45-degree field of view
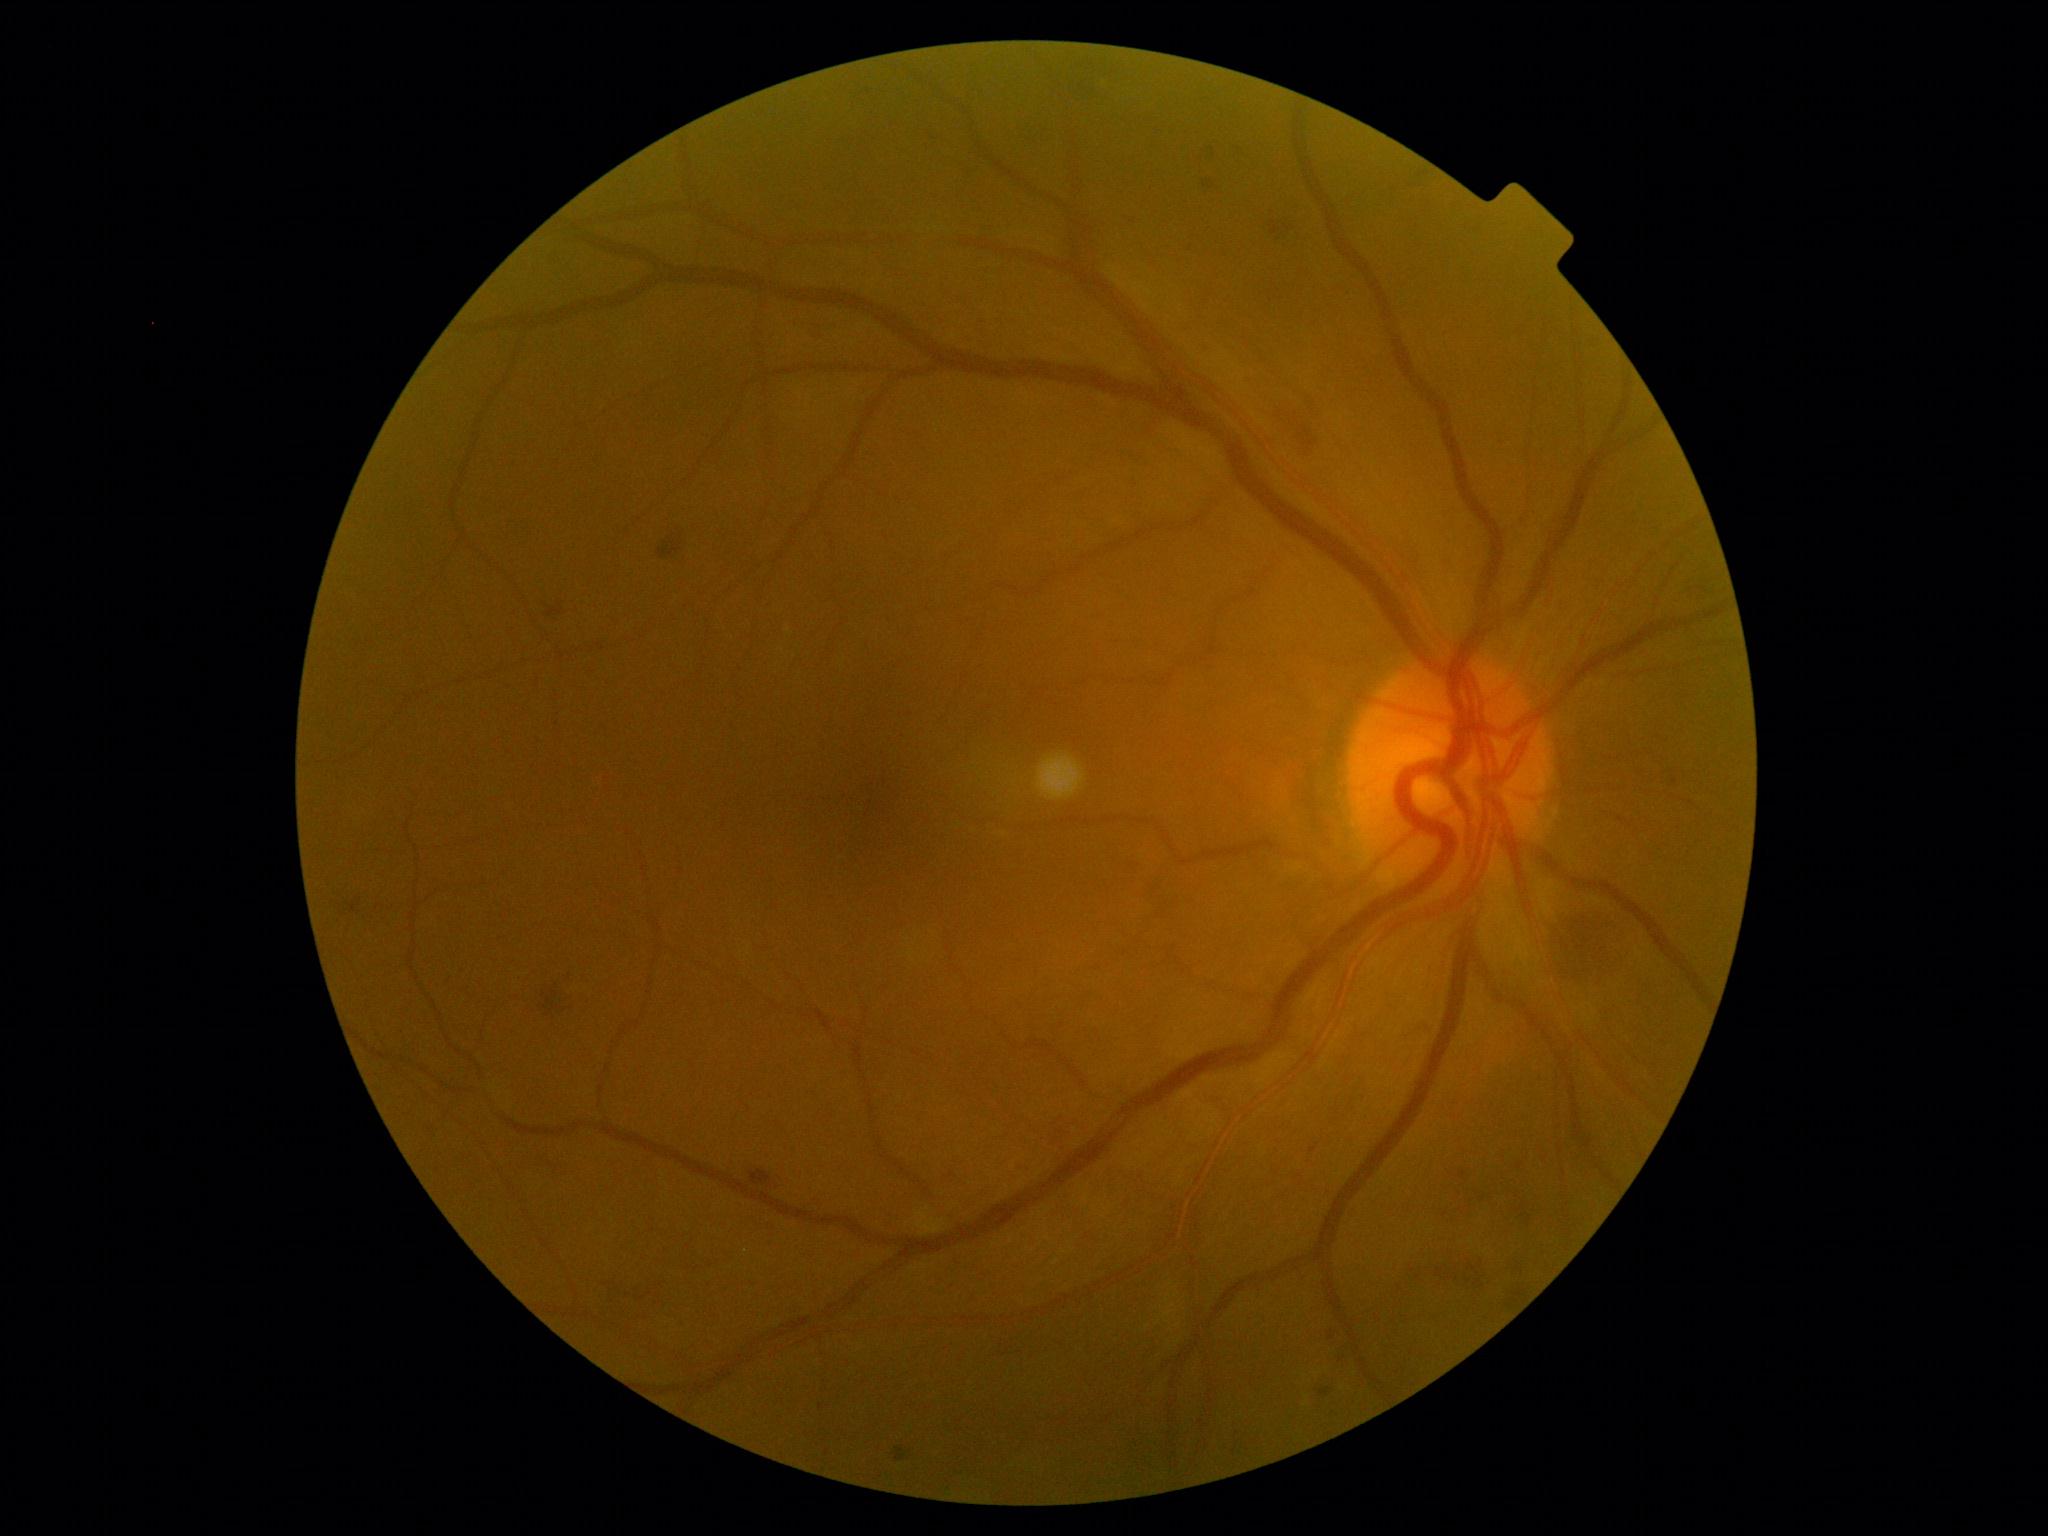

Diabetic retinopathy (DR): grade 2.